Modified Davis classification
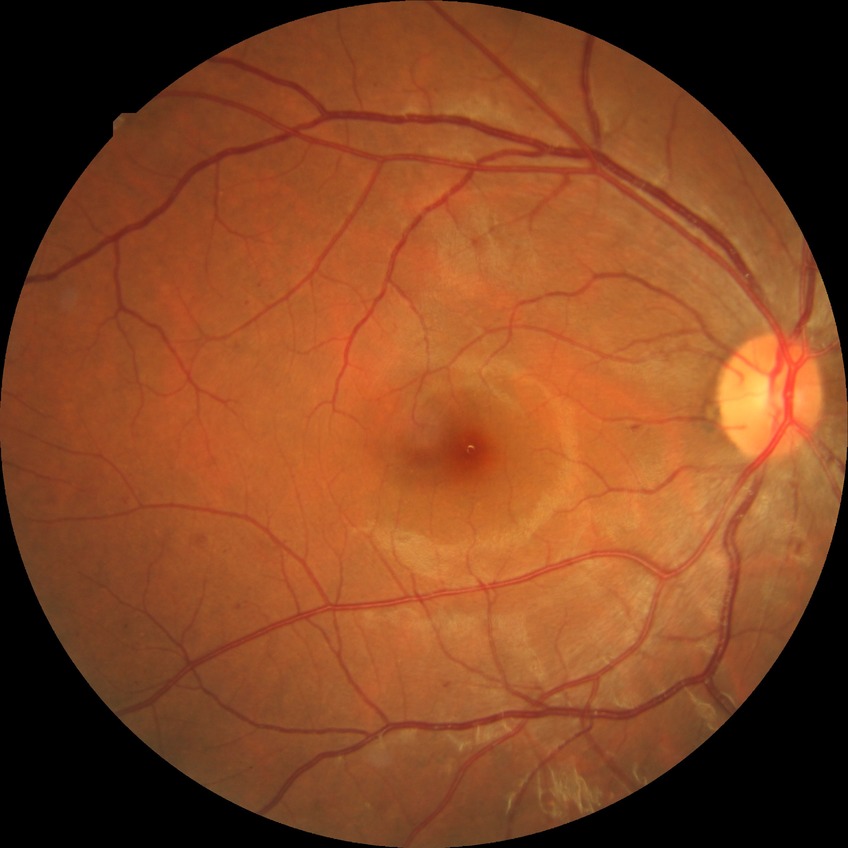 {
  "davis_grade": "SDR"
}